100° field of view (Phoenix ICON); infant wide-field retinal image:
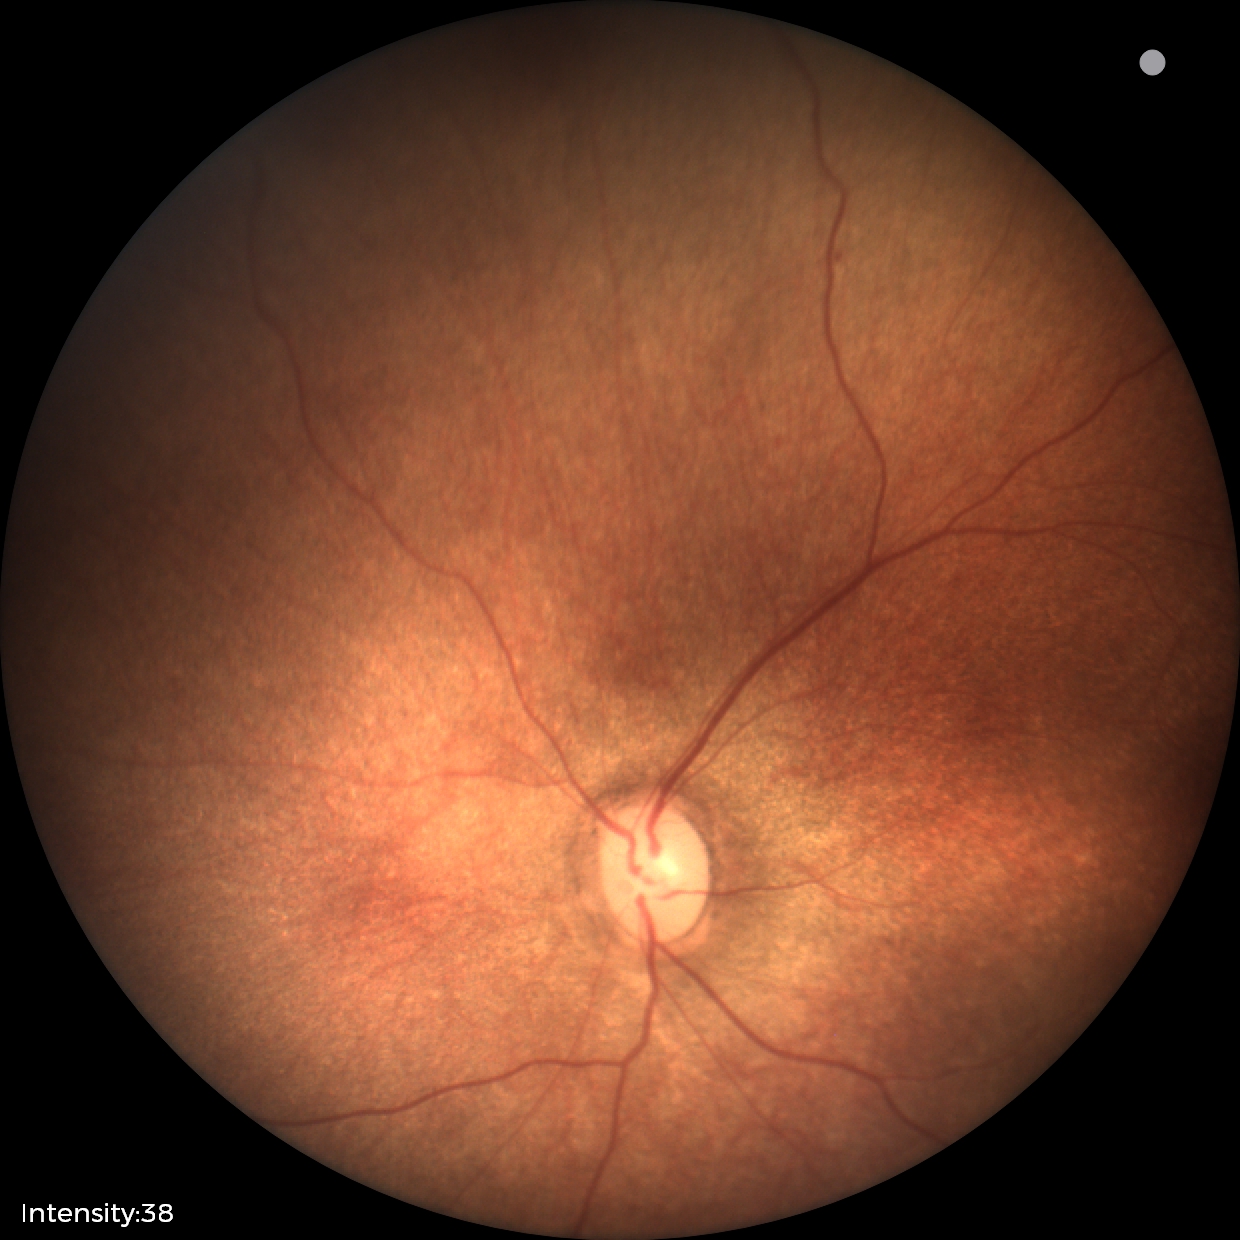 Finding = no abnormalities.